Wide-field fundus photograph of an infant; 1240 by 1240 pixels: 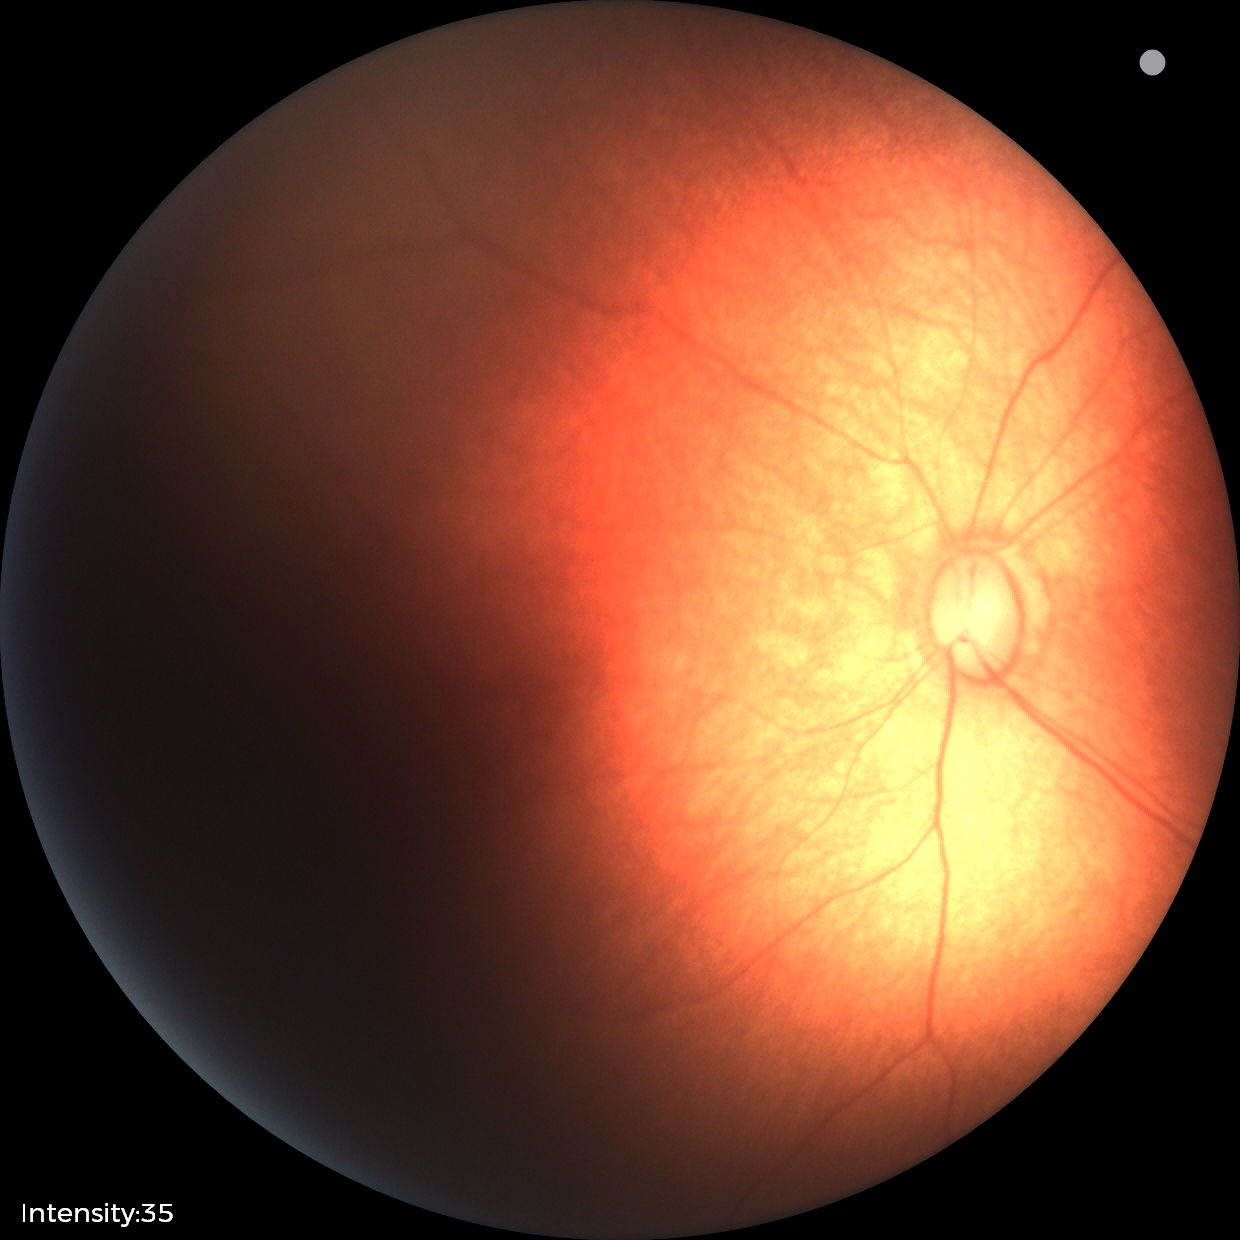
Impression: physiological appearance.